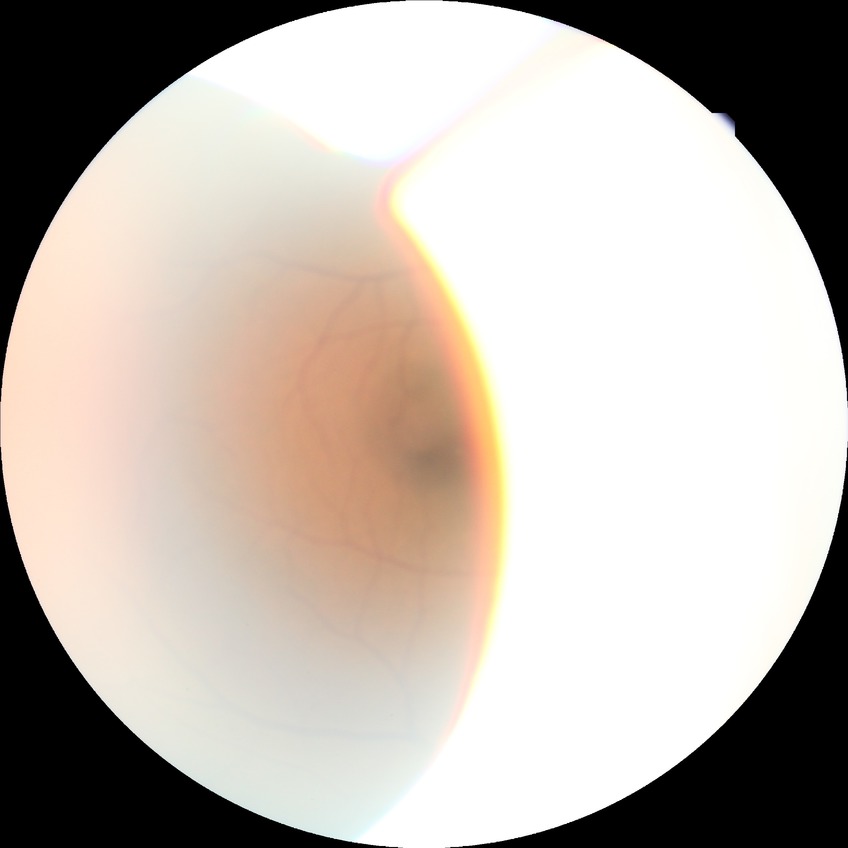
modified Davis grade=SDR; DR class=non-proliferative diabetic retinopathy.